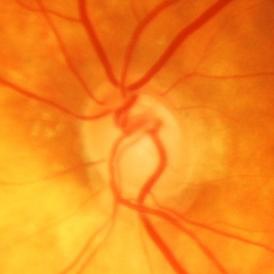 Glaucoma status: present.